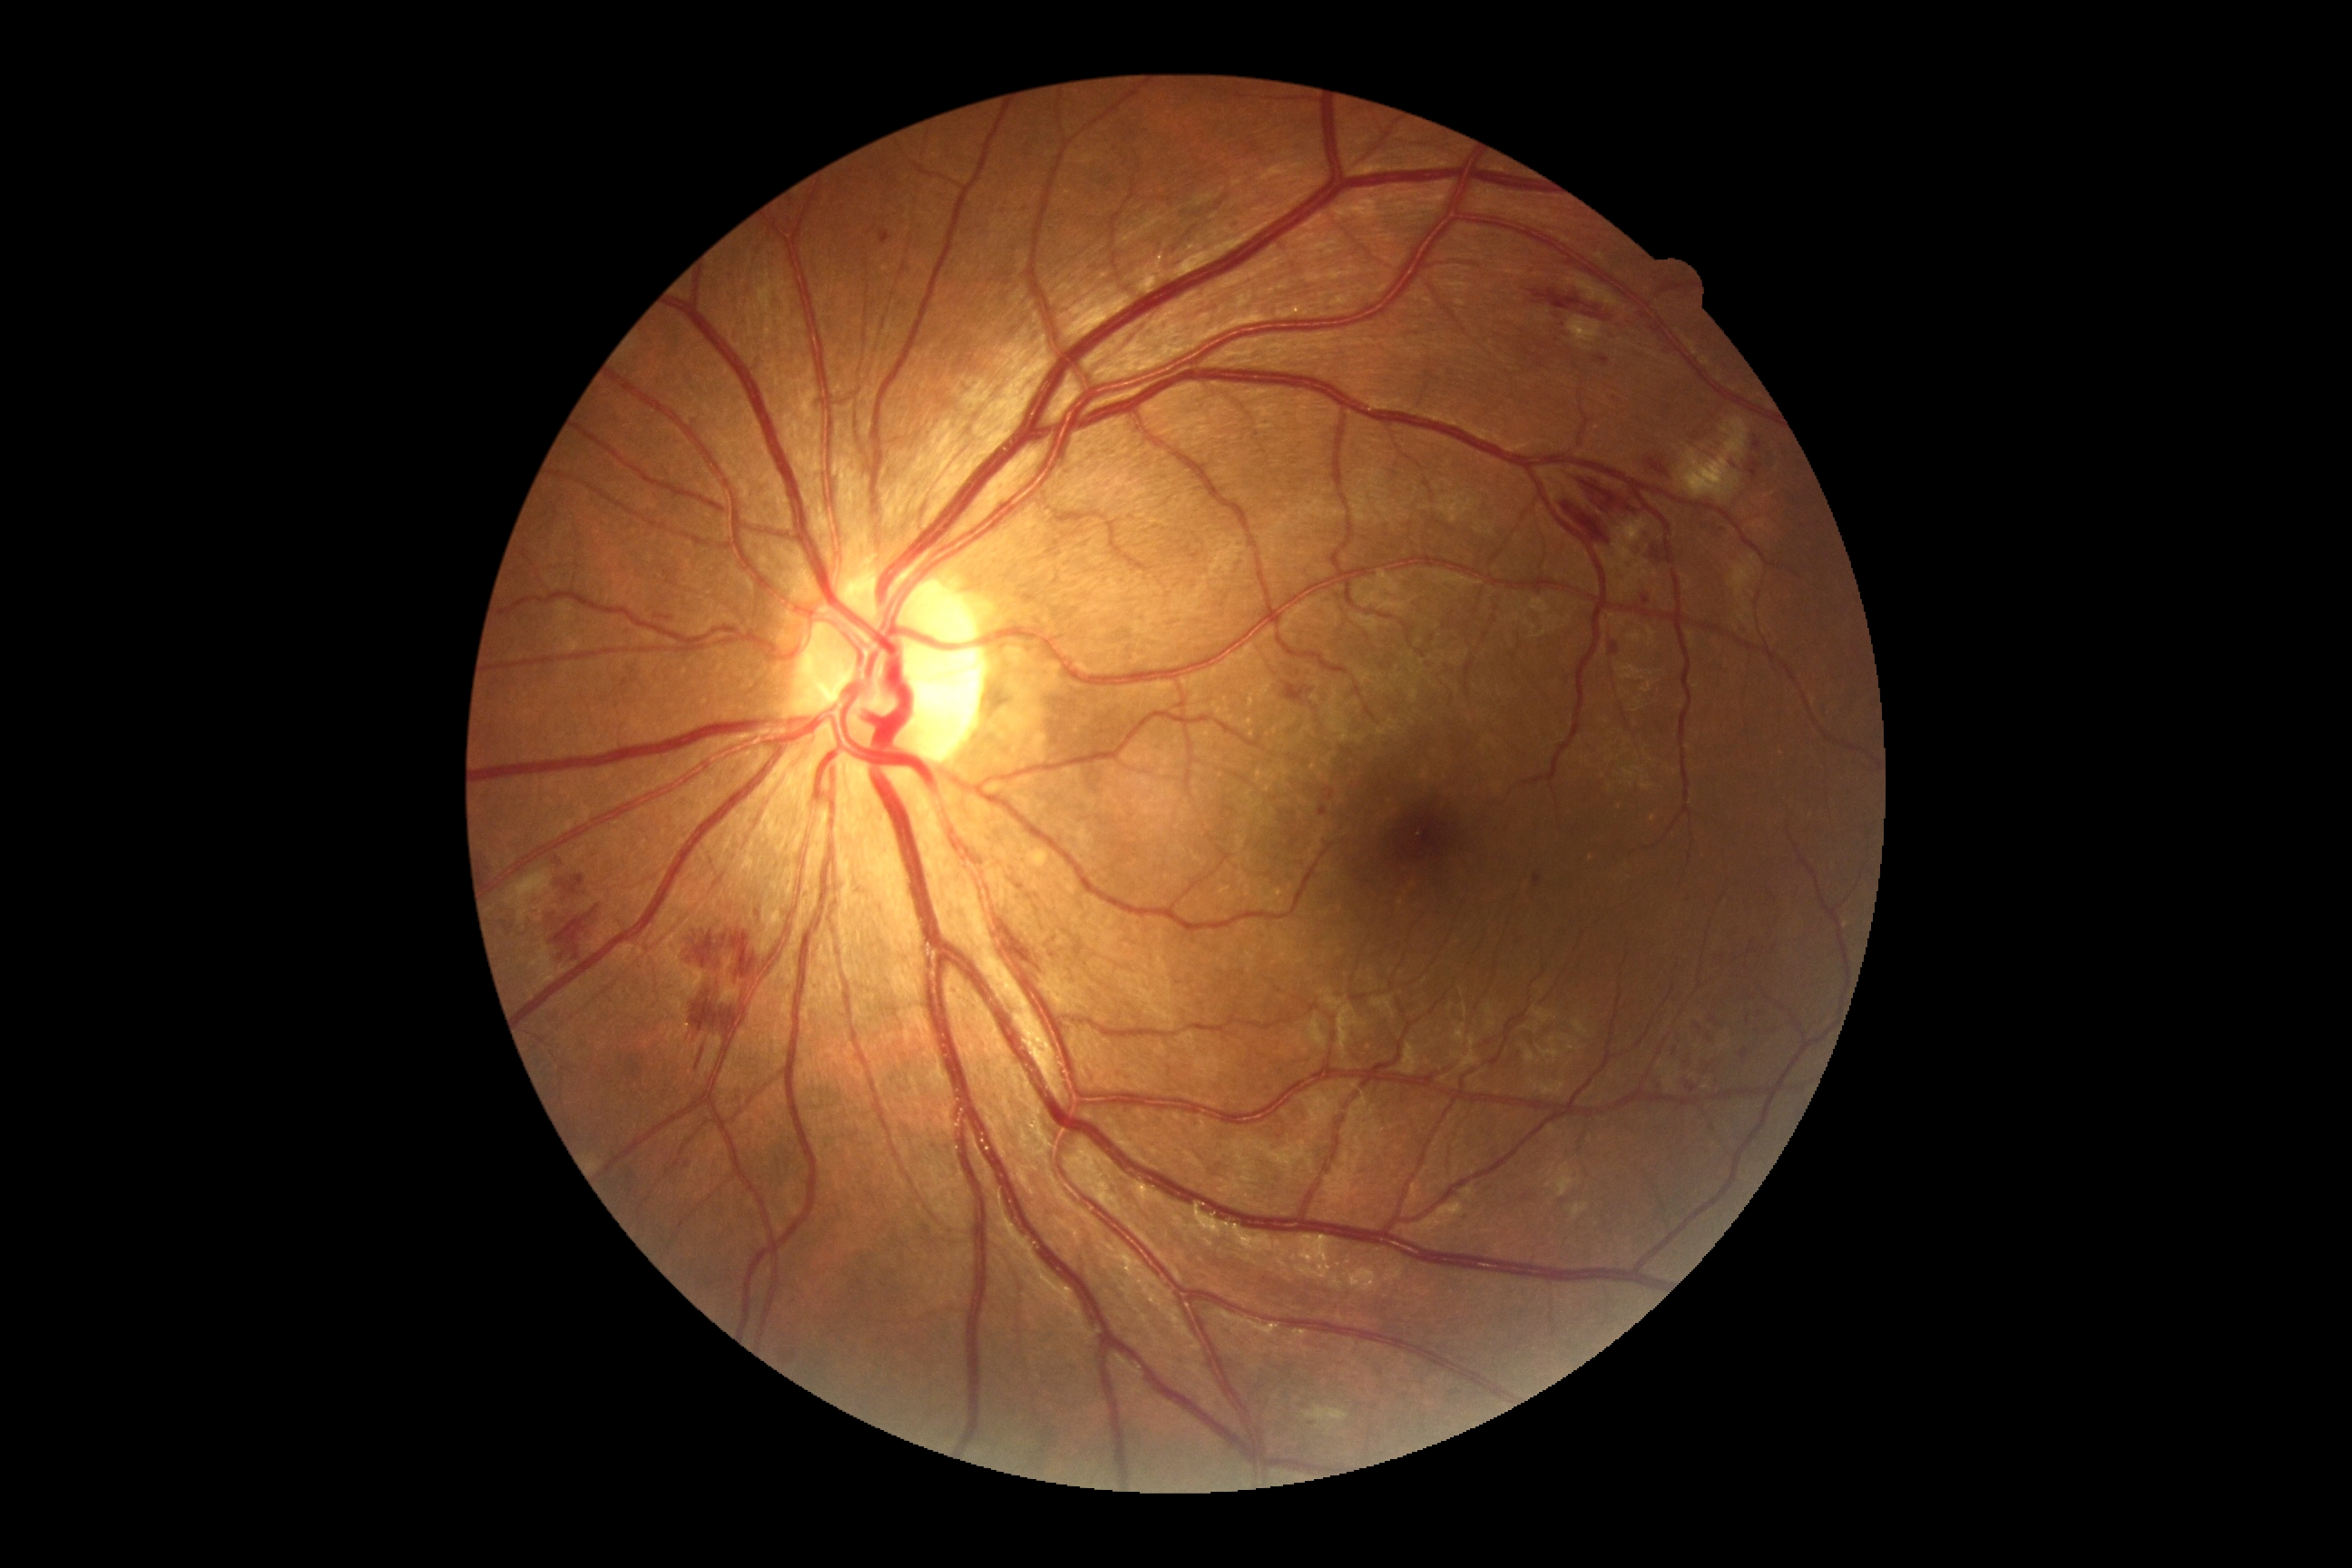

dr_grade: 2/4 — more than just microaneurysms but less than severe NPDR